DR severity per modified Davis staging: 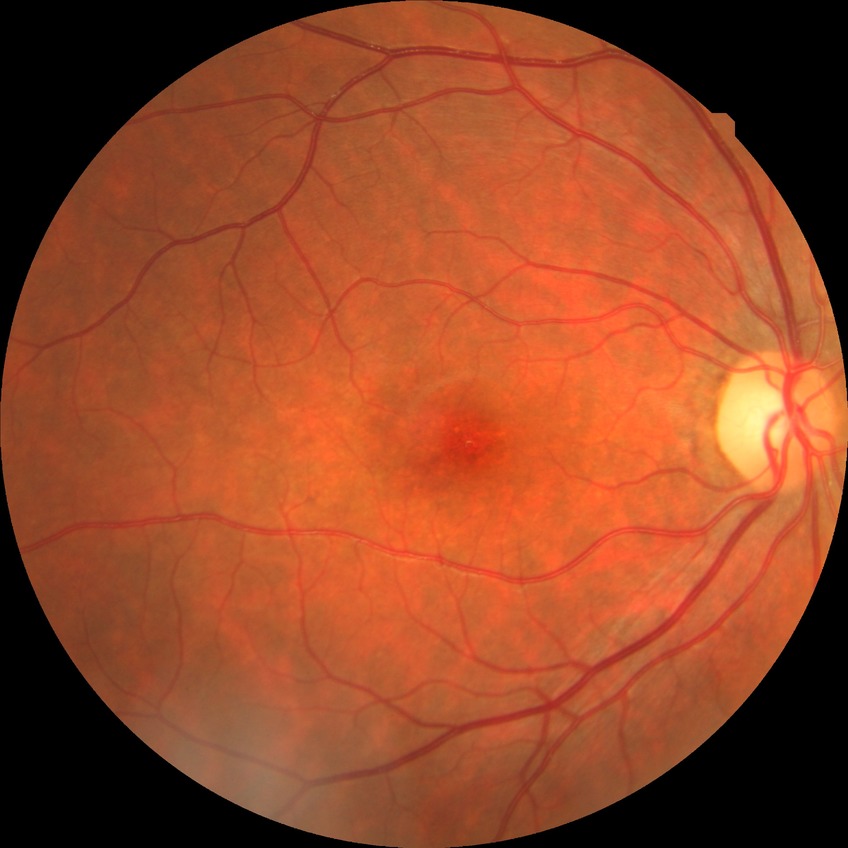

  davis_grade: NDR